Posterior pole photograph; nonmydriatic; NIDEK AFC-230; 848 x 848 pixels — 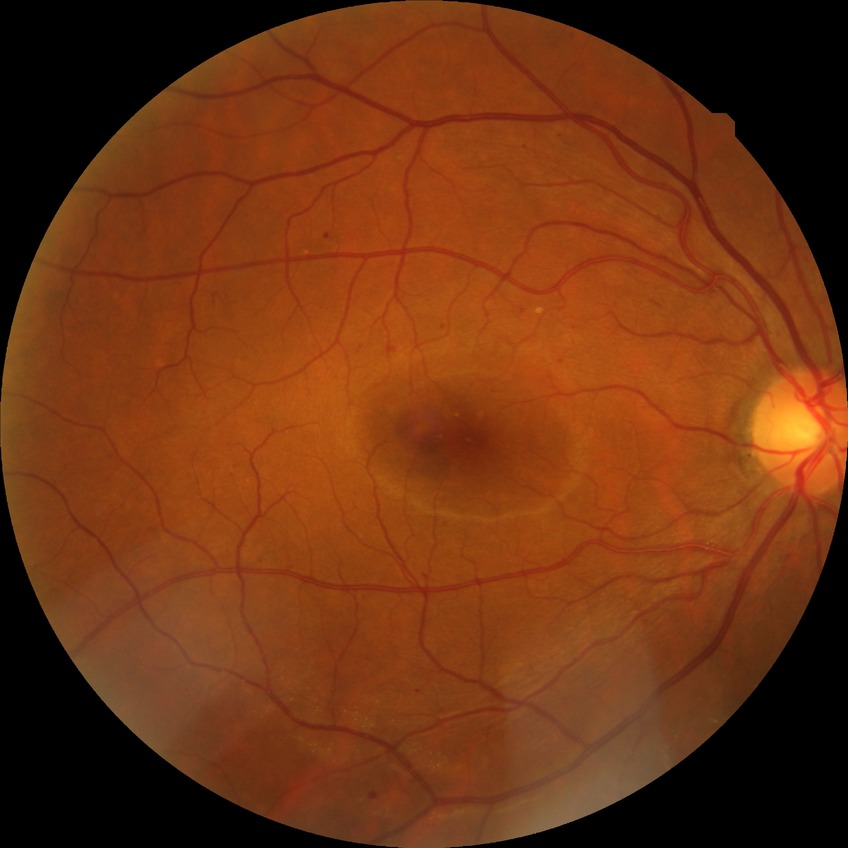 The retinopathy is classified as non-proliferative diabetic retinopathy.
Diabetic retinopathy (DR) is simple diabetic retinopathy (SDR).